NIDEK AFC-230. Diabetic retinopathy graded by the modified Davis classification. Color fundus image.
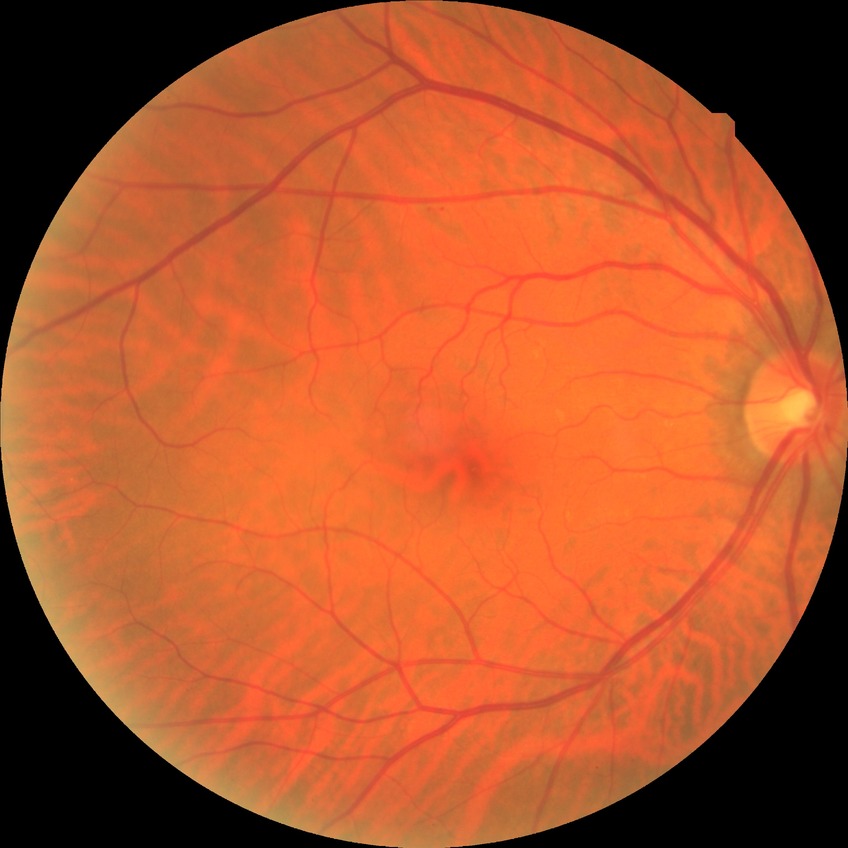
diabetic retinopathy (DR): simple diabetic retinopathy (SDR).